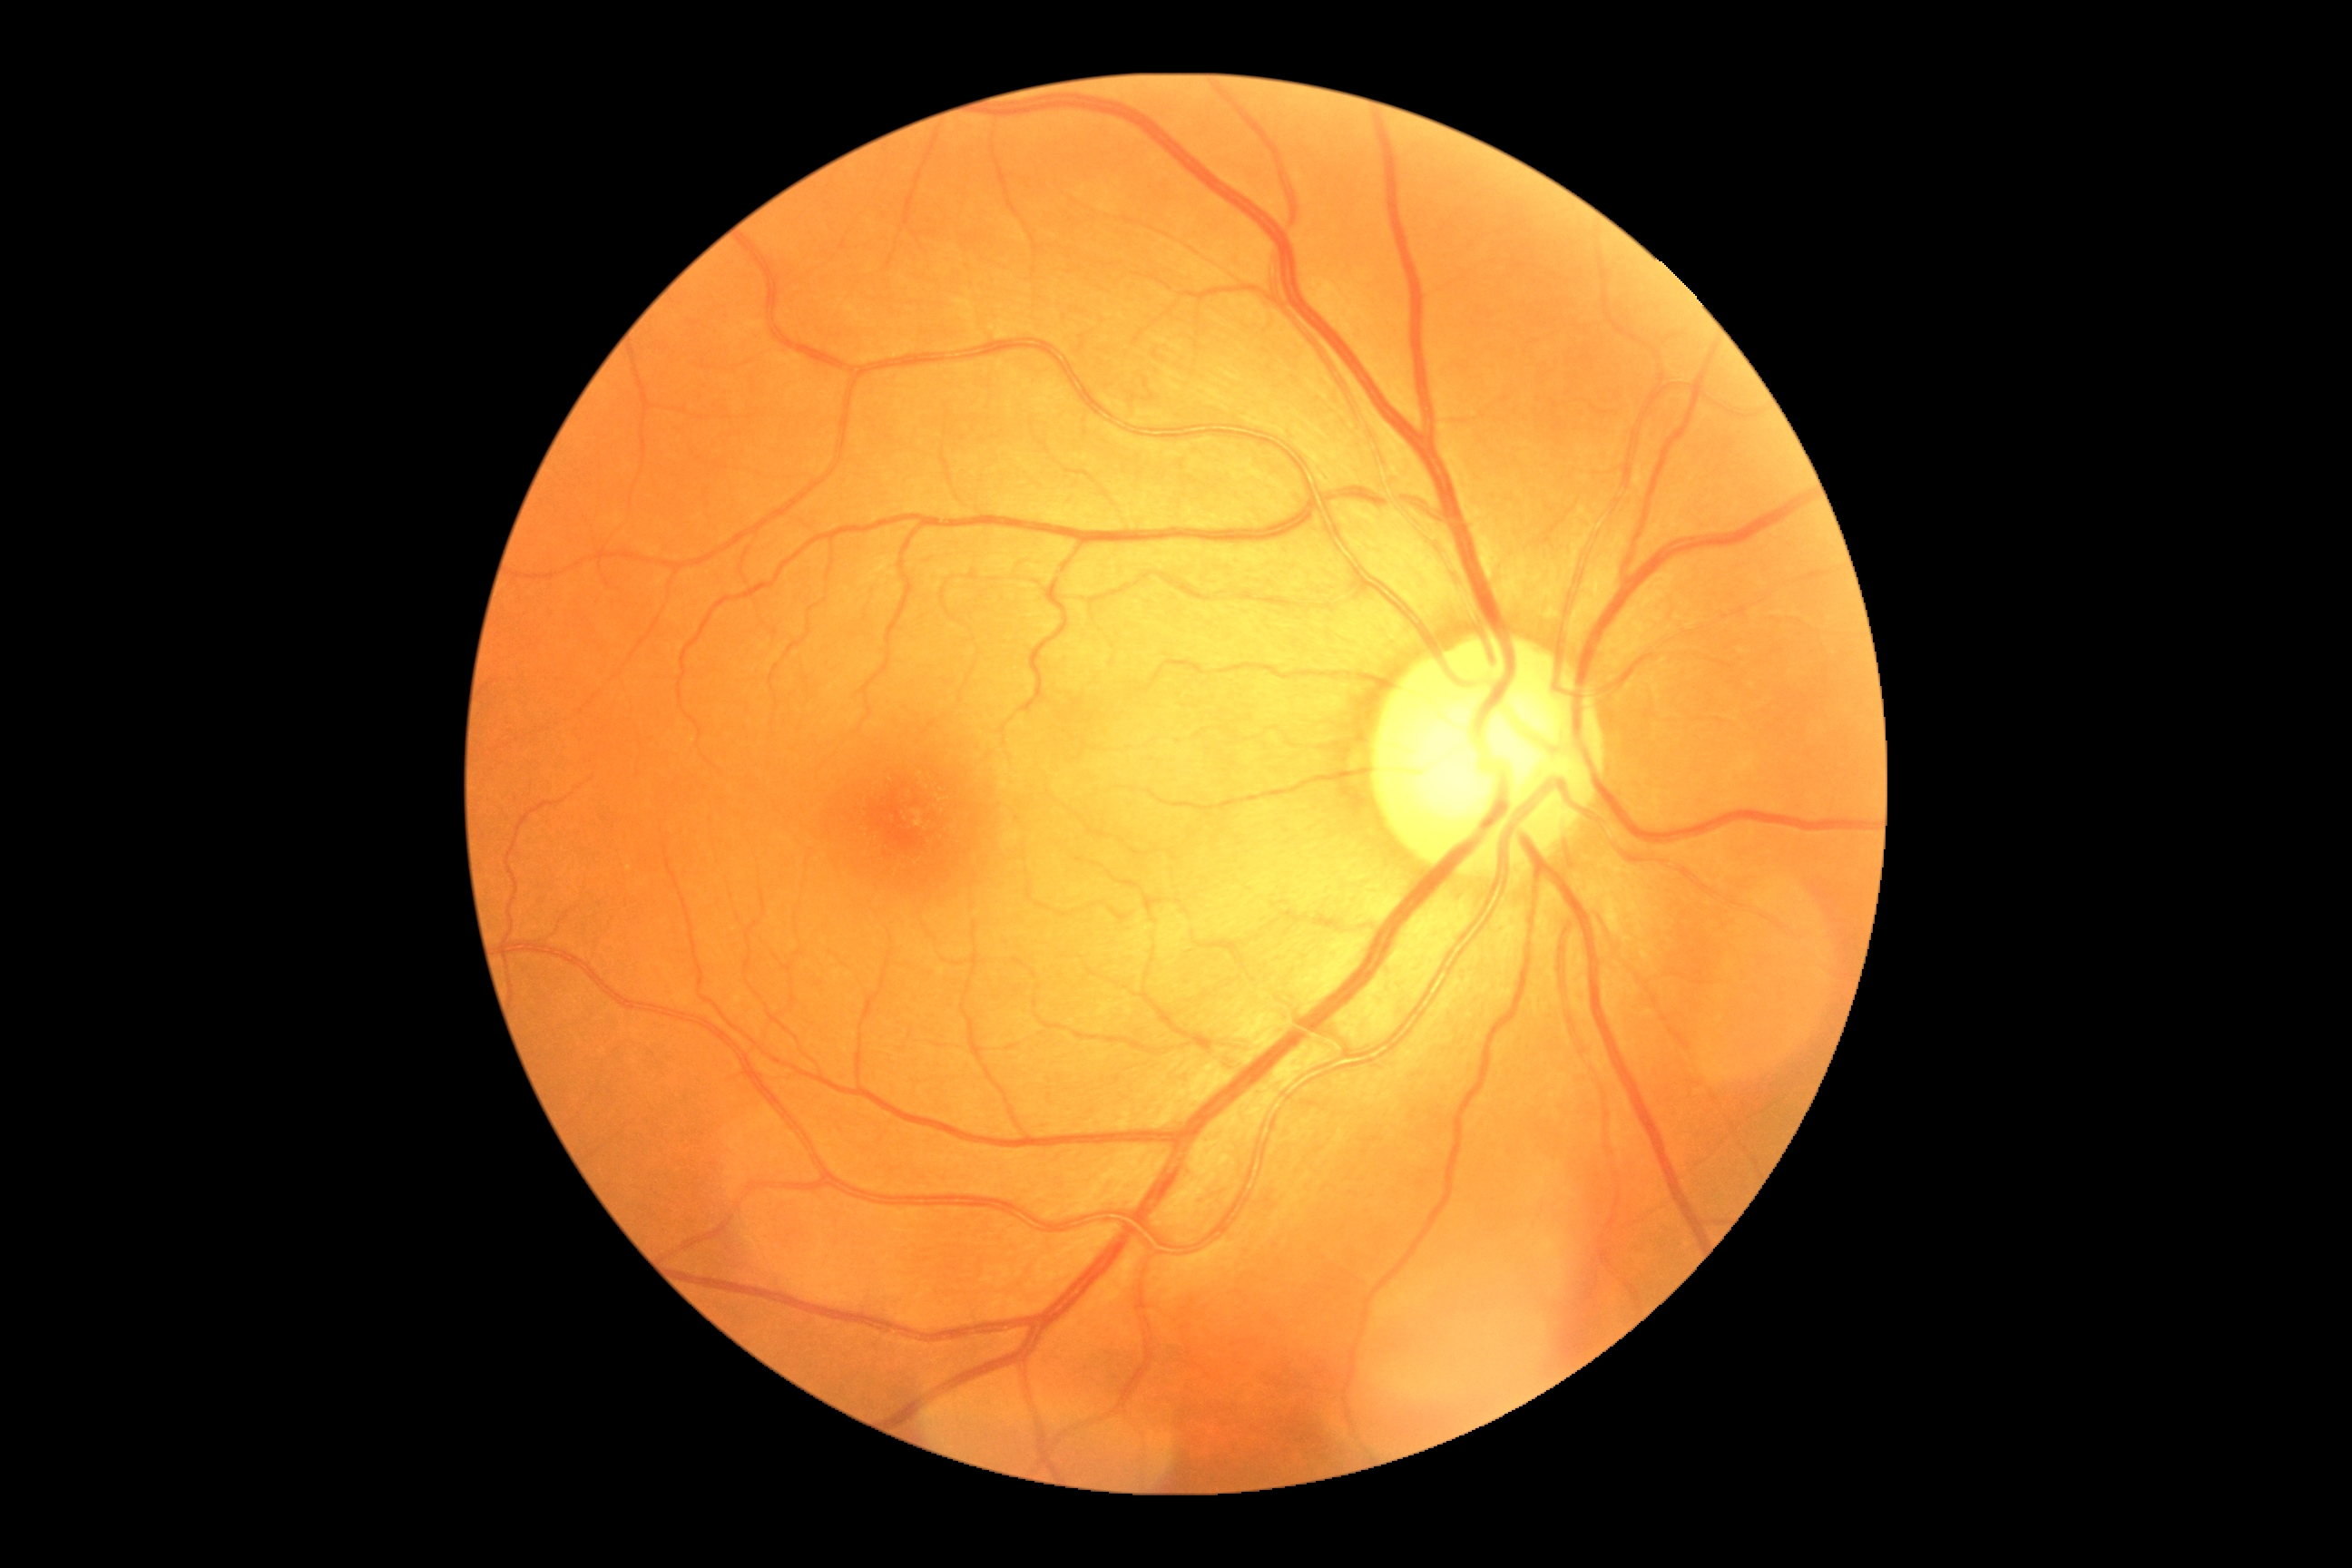

Findings:
- DR impression: no apparent DR
- diabetic retinopathy (DR): grade 0 (no apparent retinopathy) — no visible signs of diabetic retinopathy